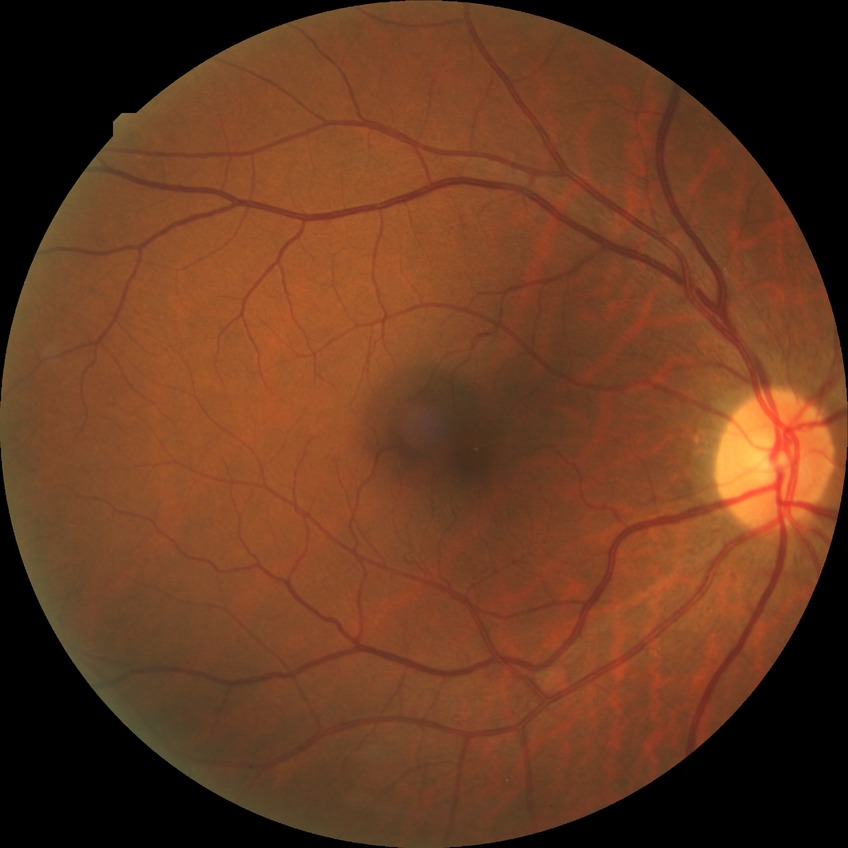

Diabetic retinopathy (DR) is NDR (no diabetic retinopathy).